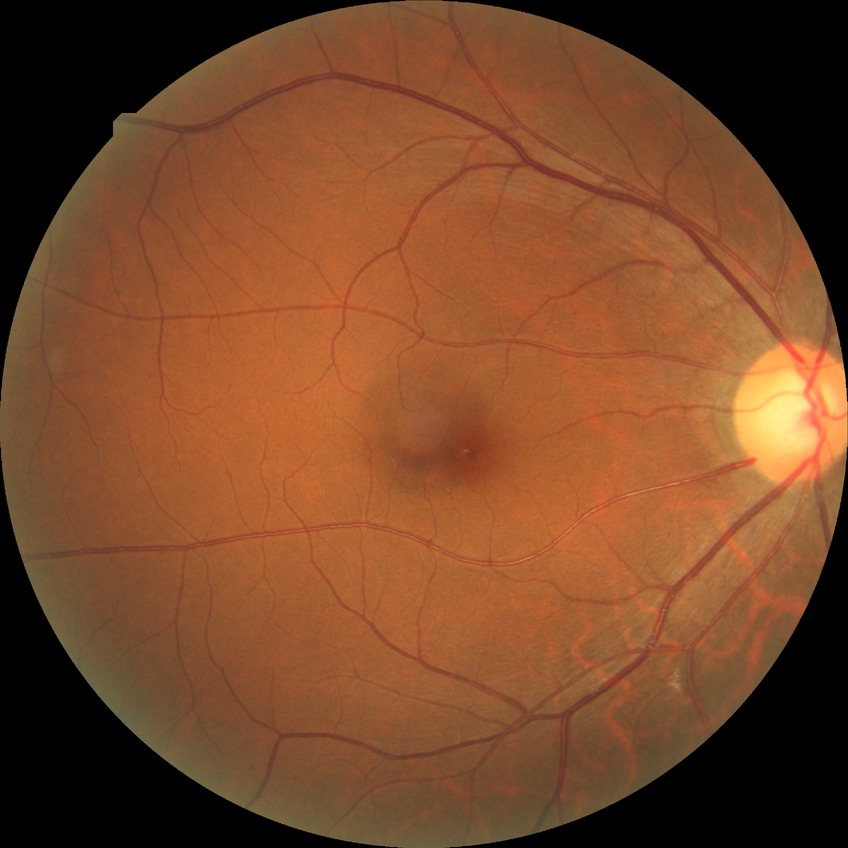
DR class = non-proliferative diabetic retinopathy
diabetic retinopathy (DR) = SDR (simple diabetic retinopathy)